Color fundus photograph. Acquired with a Remidio Fundus on Phone (FOP) camera — 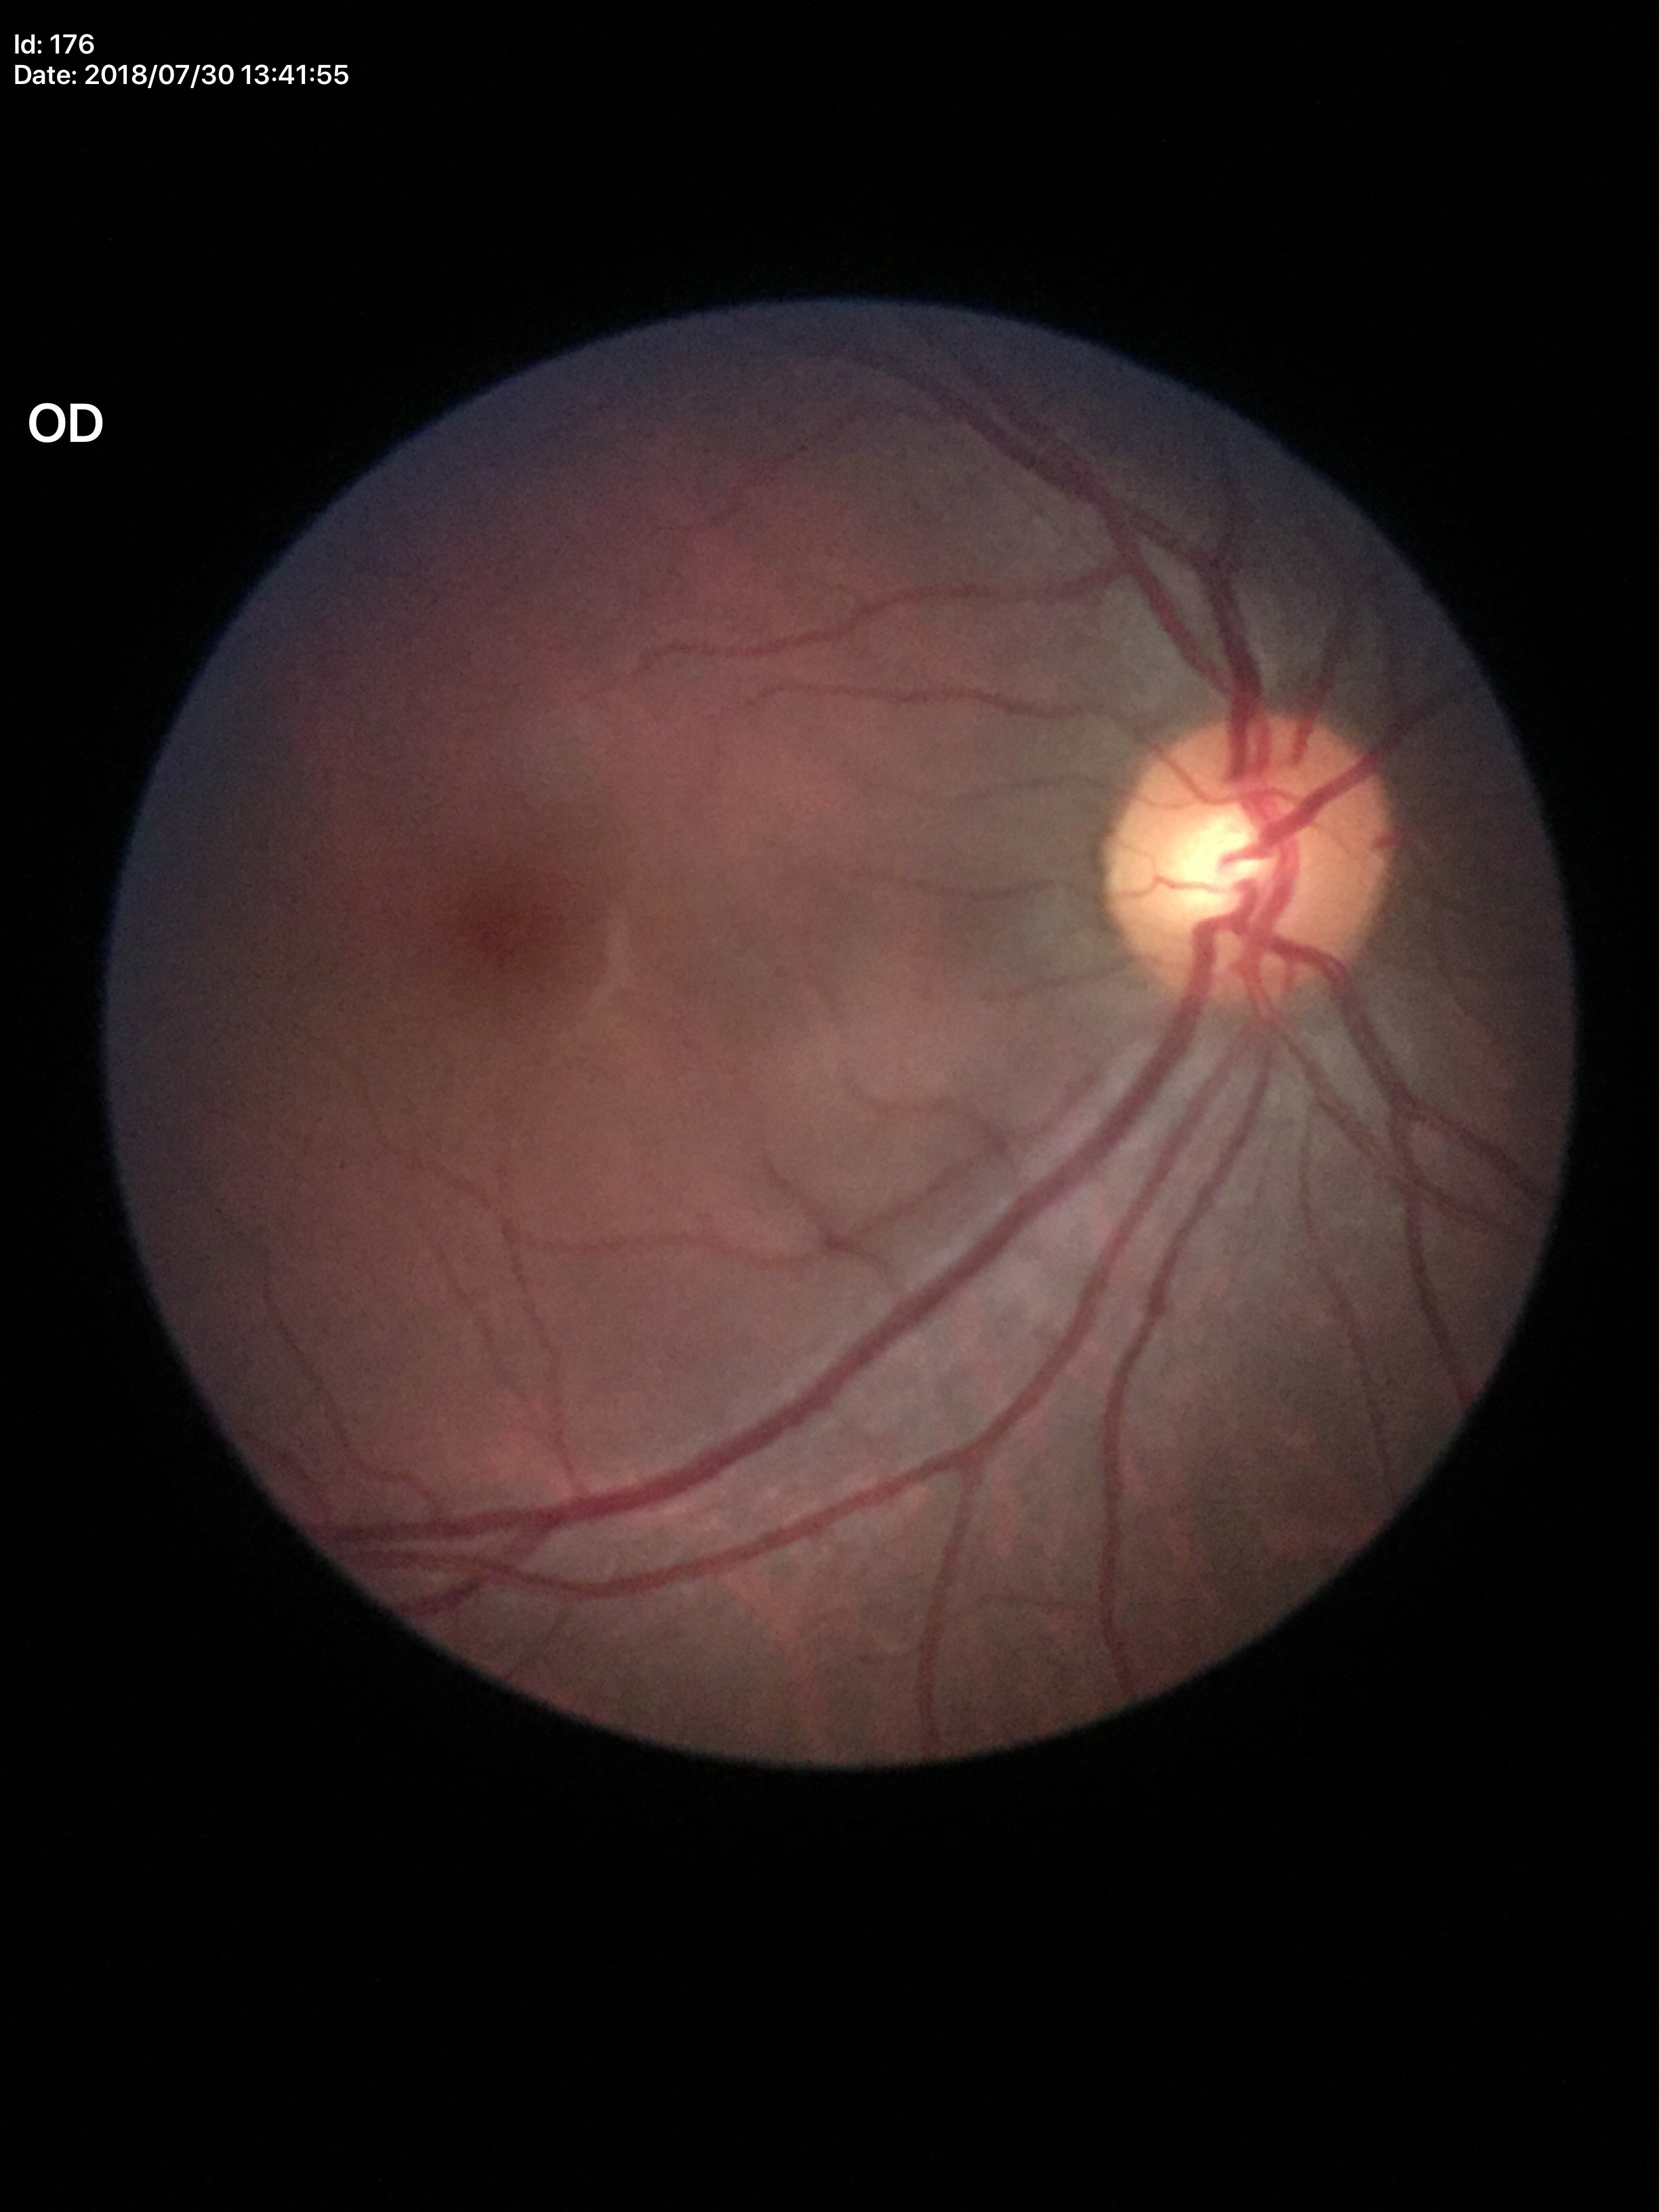

Glaucoma decision=negative | vertical C/D ratio=0.51 | area cup-to-disc ratio=0.27